Graded on the modified Davis scale
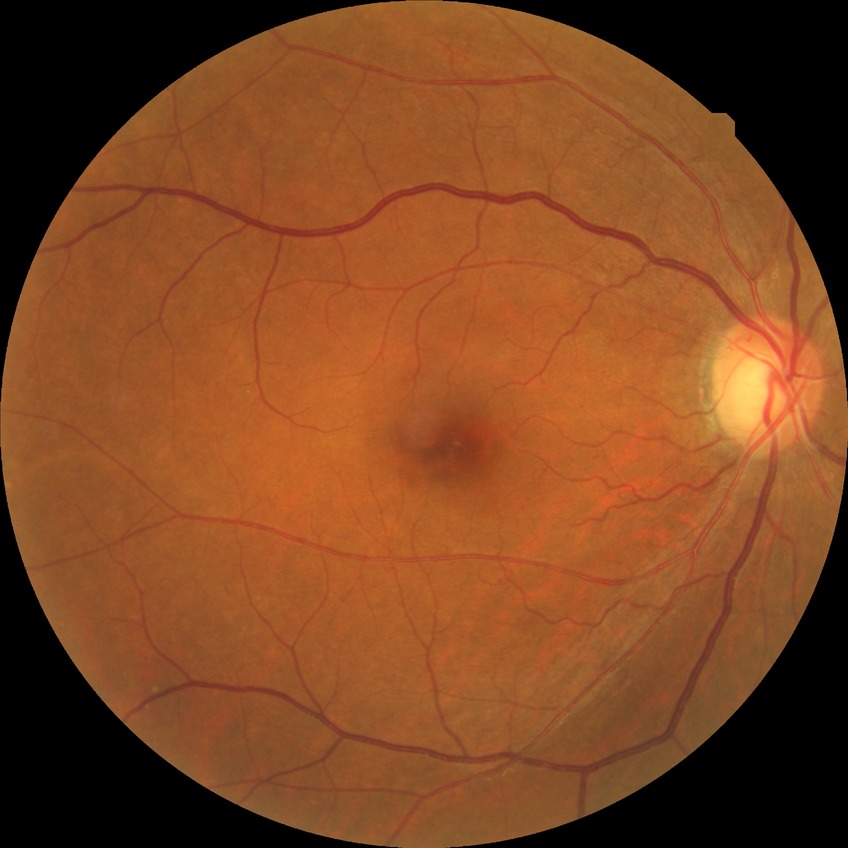
• diabetic retinopathy (DR) — no diabetic retinopathy (NDR)